Fundus photo. 45° field of view: 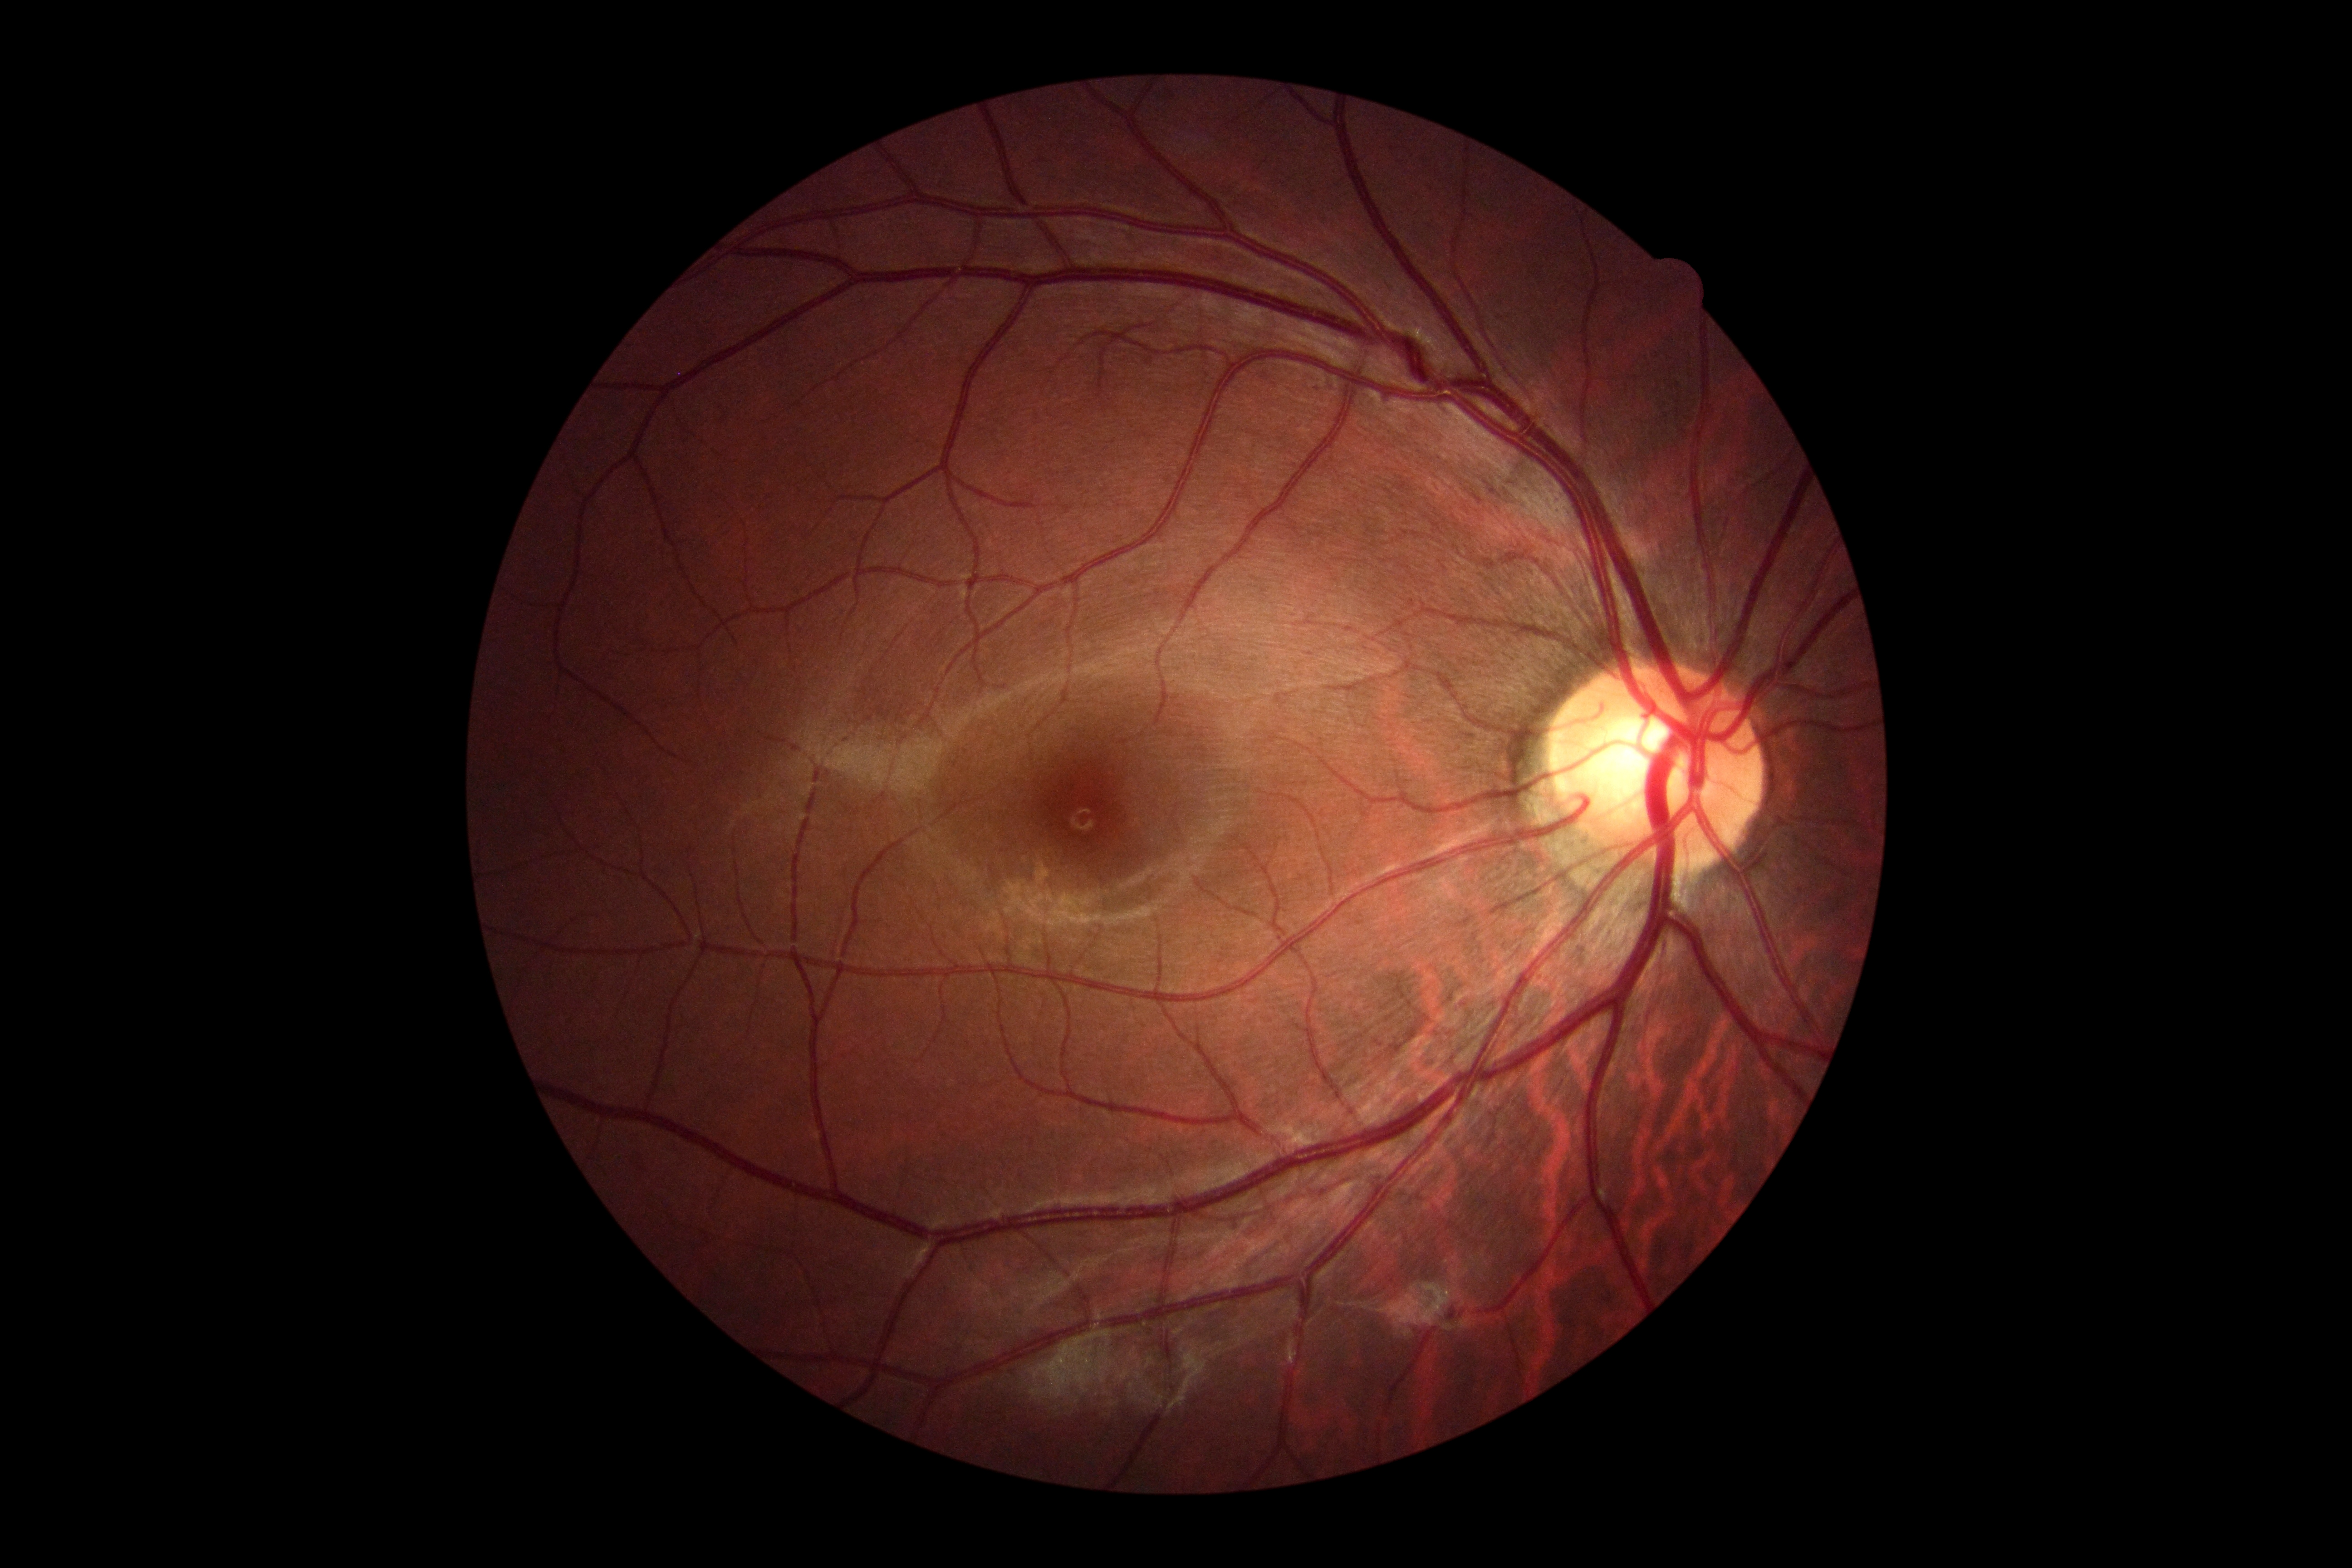 * diabetic retinopathy — grade 0